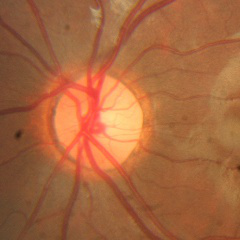 Glaucoma diagnosis = no glaucoma.